45-degree field of view; retinal fundus photograph; no pharmacologic dilation; graded on the modified Davis scale — 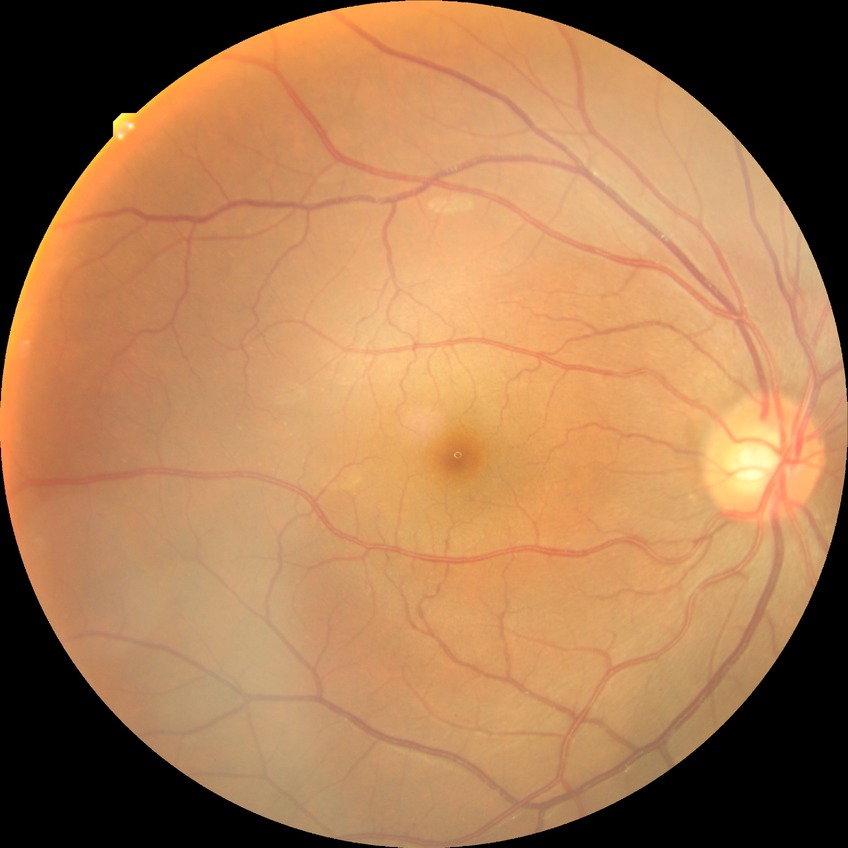

Findings:
• modified Davis classification: no diabetic retinopathy